200° FOV, ultra-widefield fundus photograph:
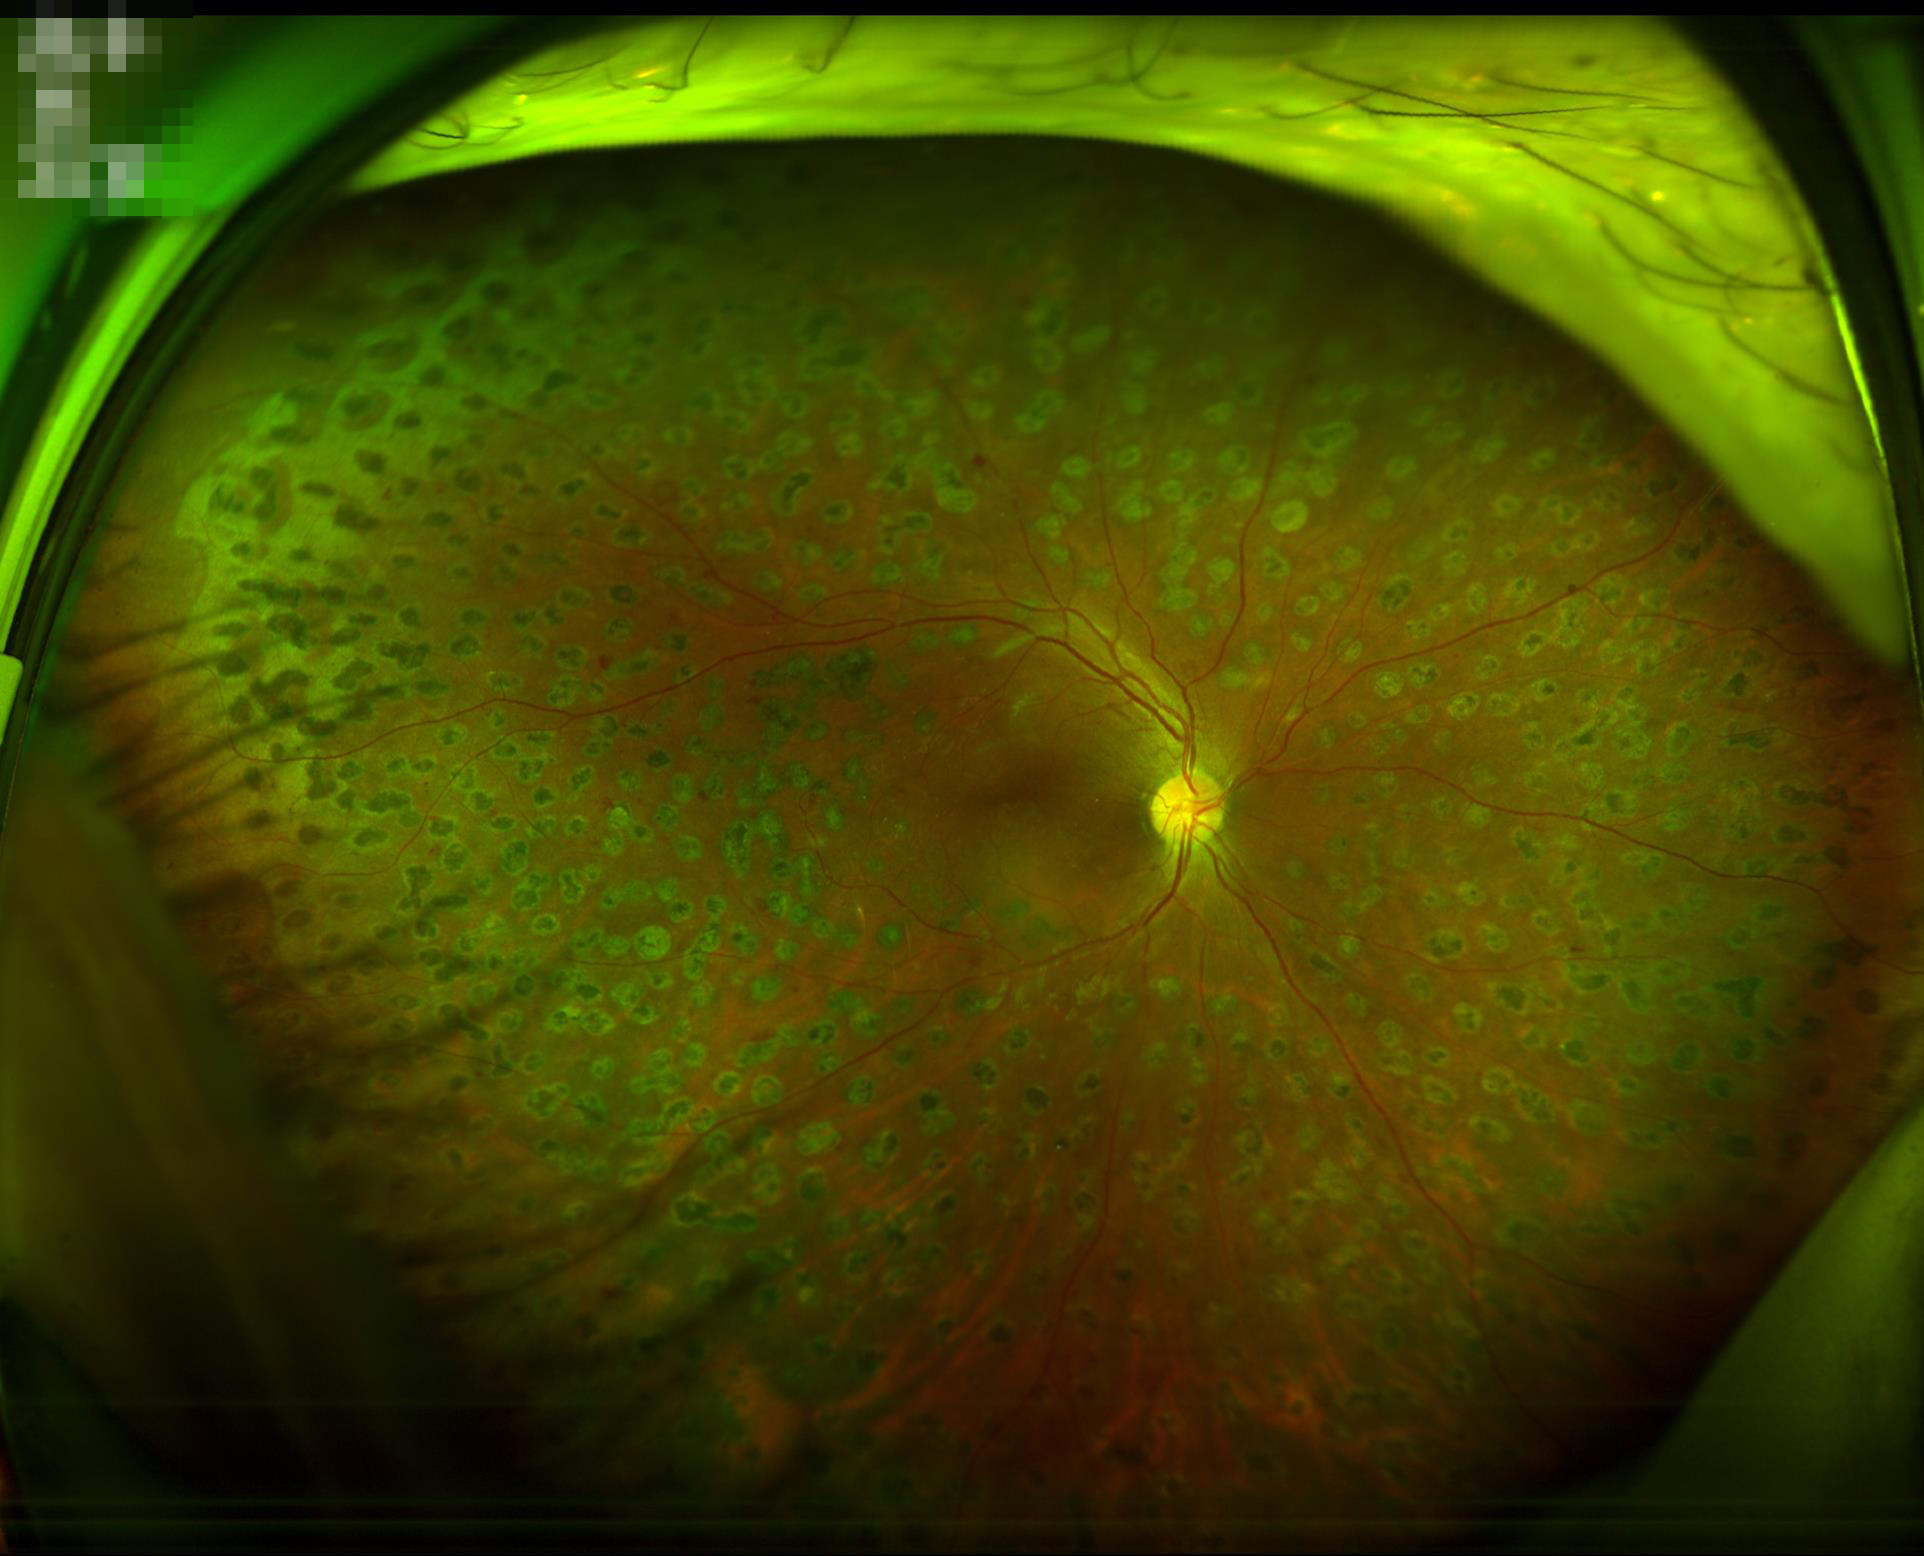

Quality grading: overall: satisfactory | illumination: satisfactory | clarity: in focus.